200-degree field of view, 1924 x 1556 pixels, ultra-widefield (UWF) fundus image — 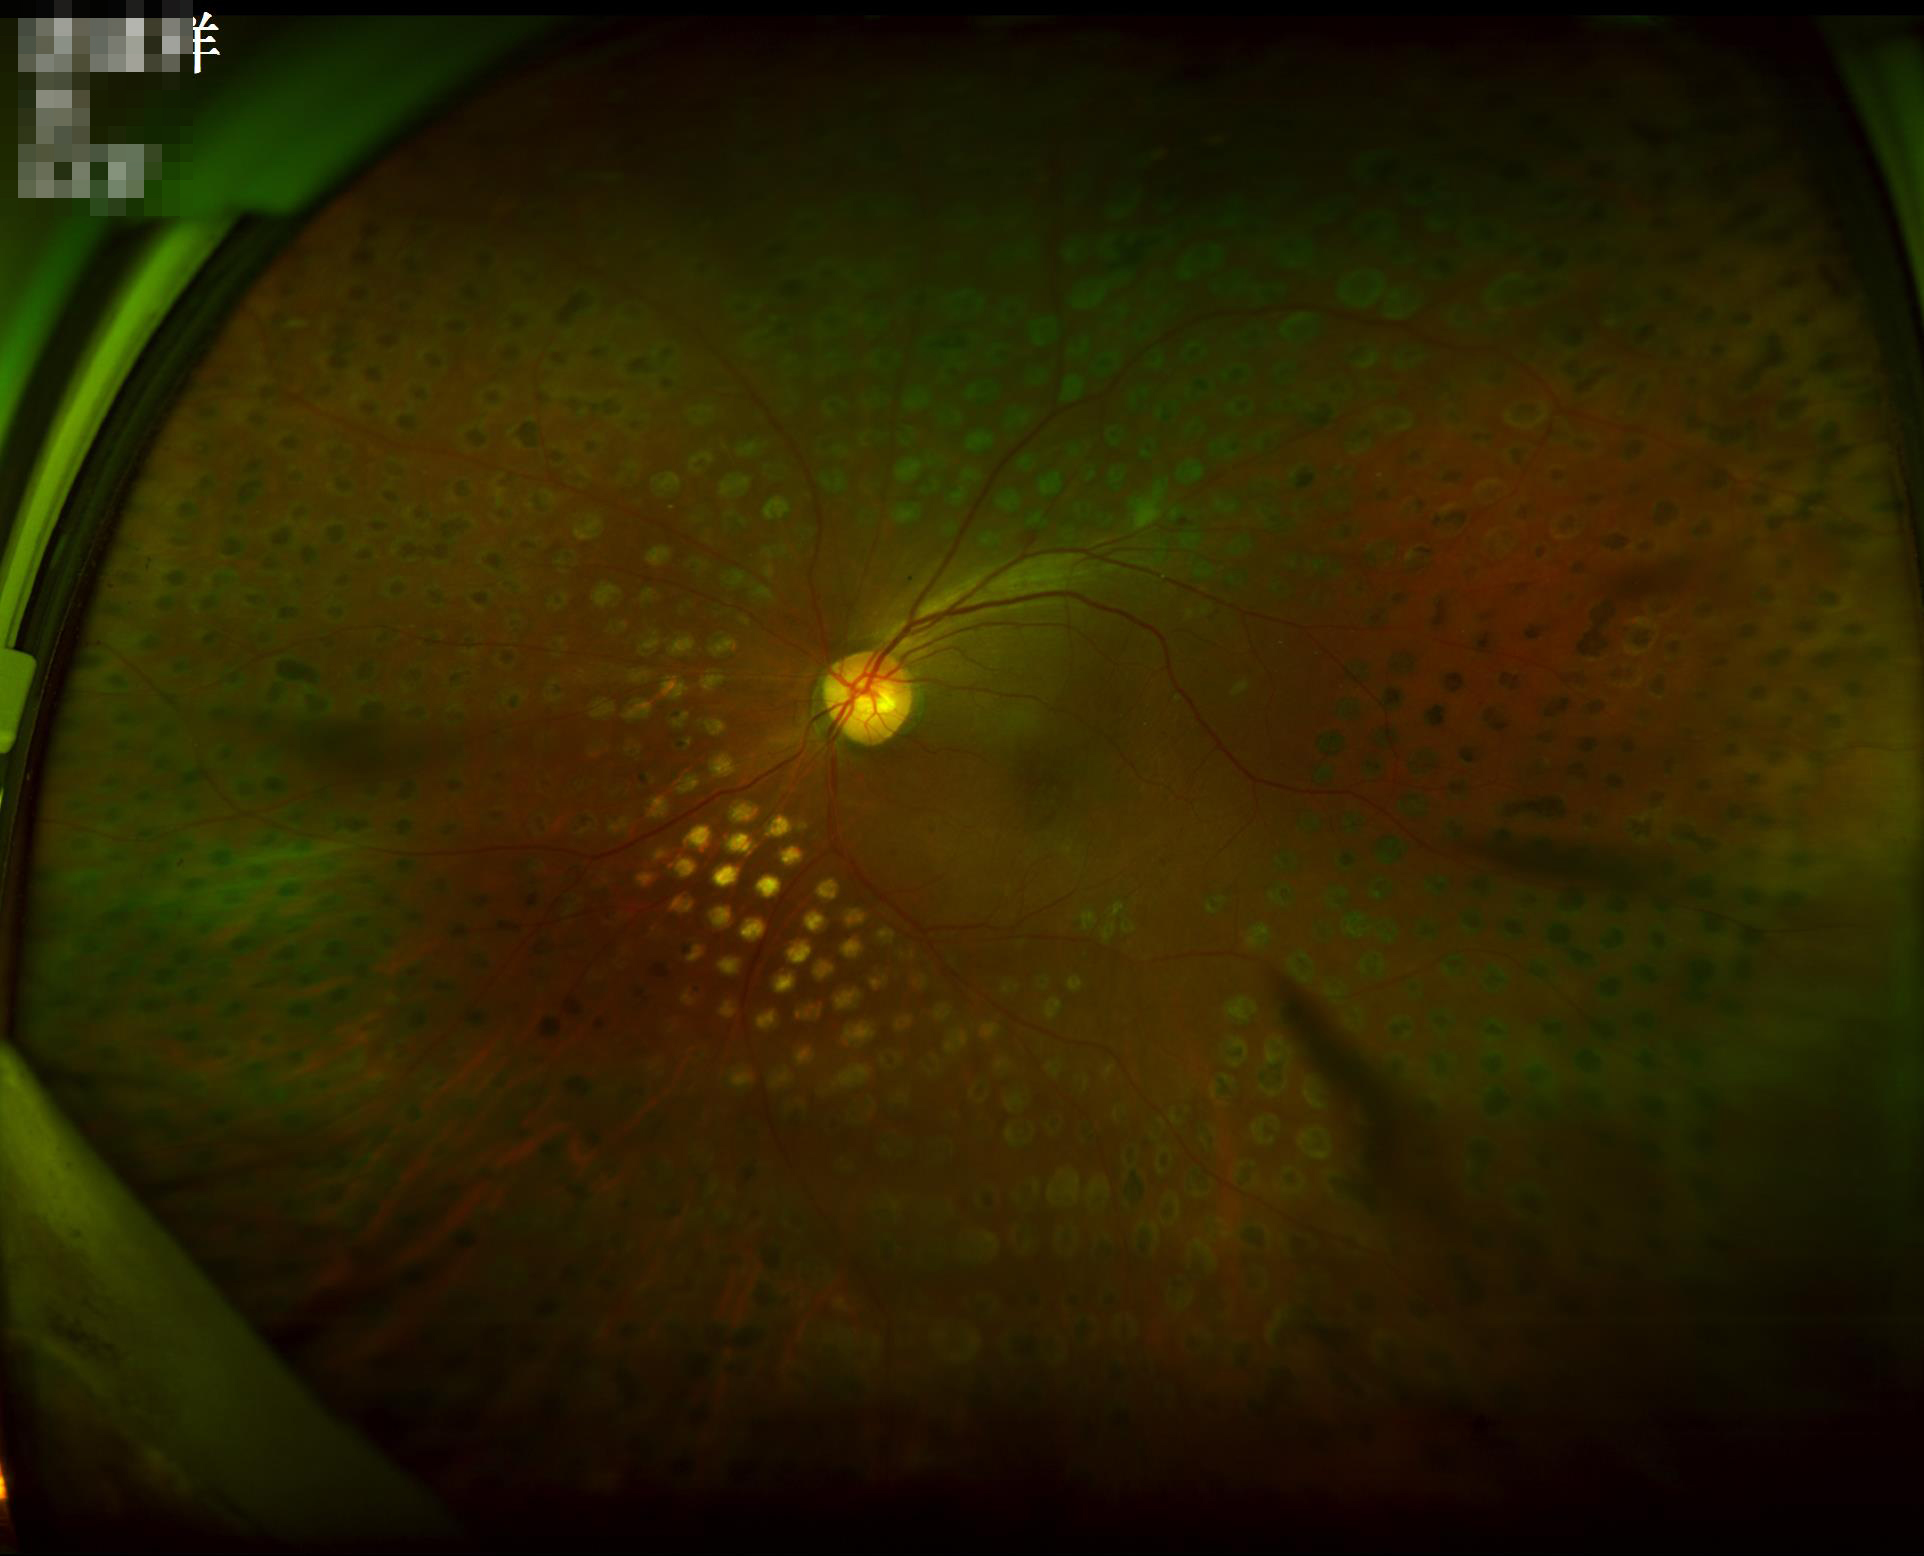
Image quality:
- illumination/color: suboptimal
- overall: adequate